1515x1275.
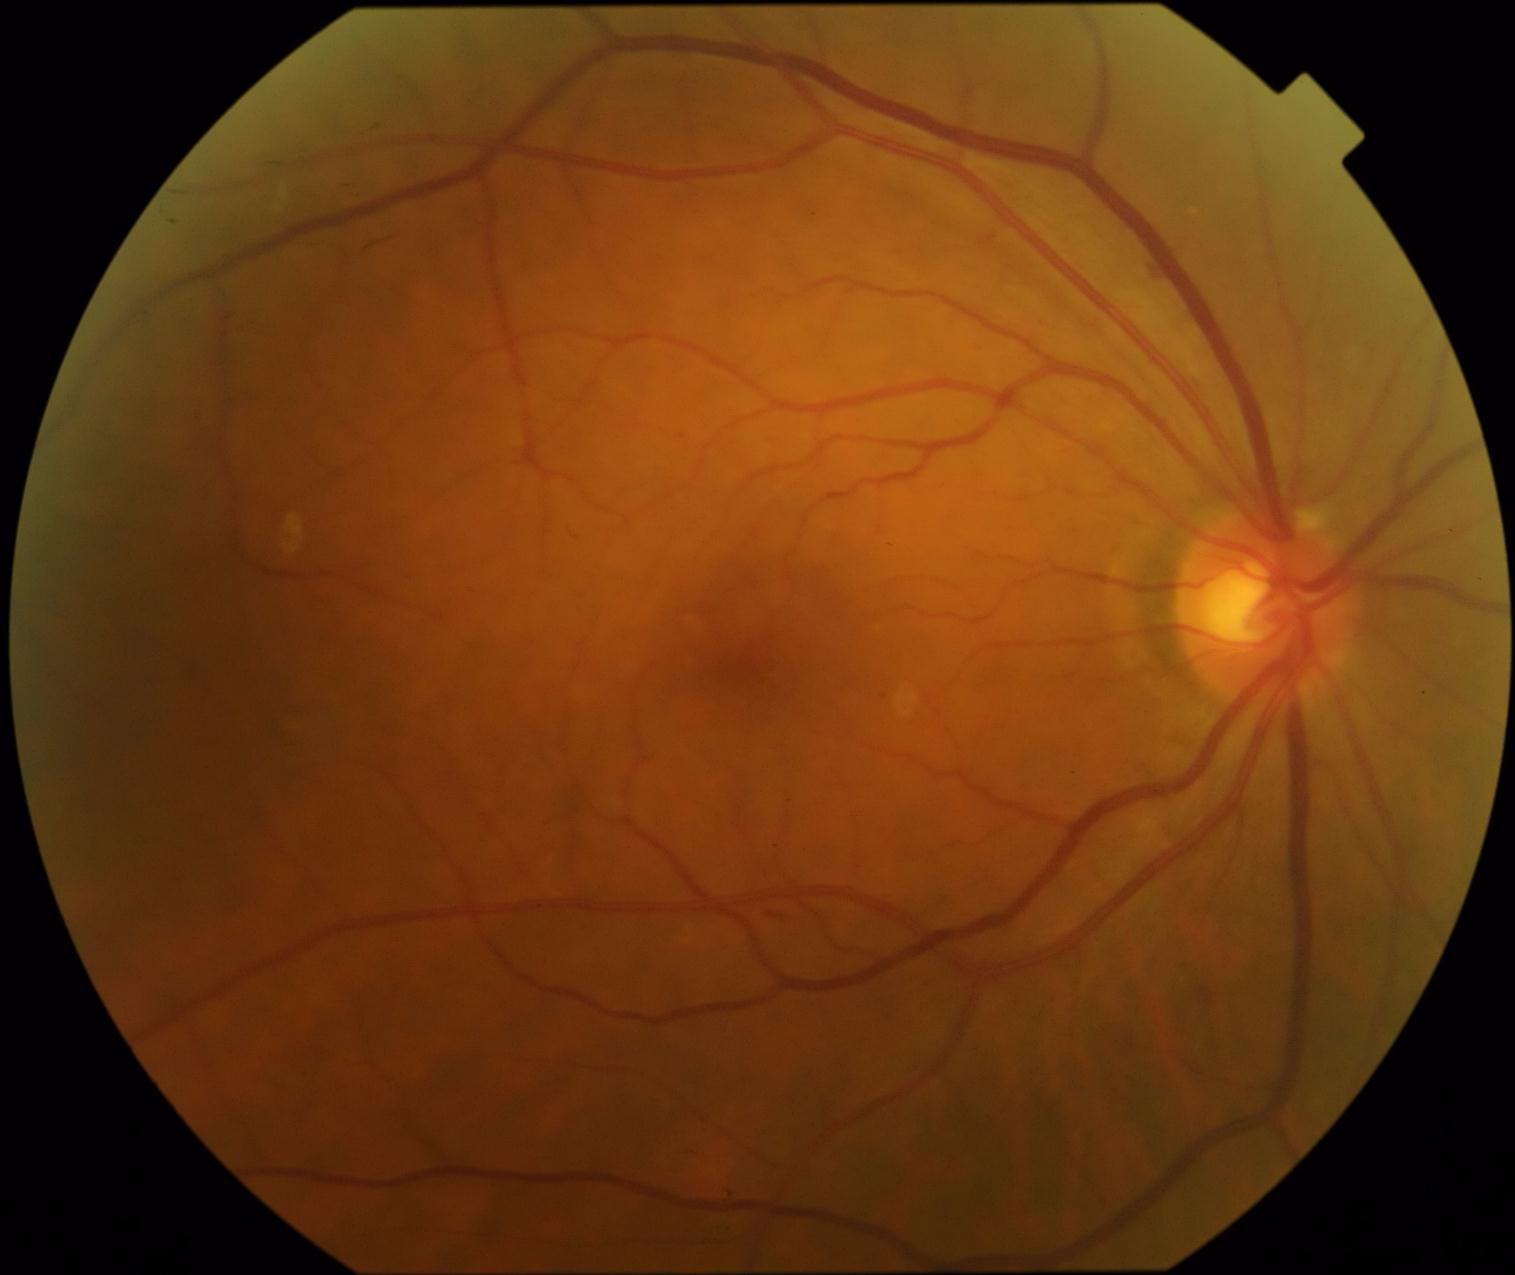

Diabetic retinopathy grade is 2.